Mydriatic (tropicamide and phenylephrine) — 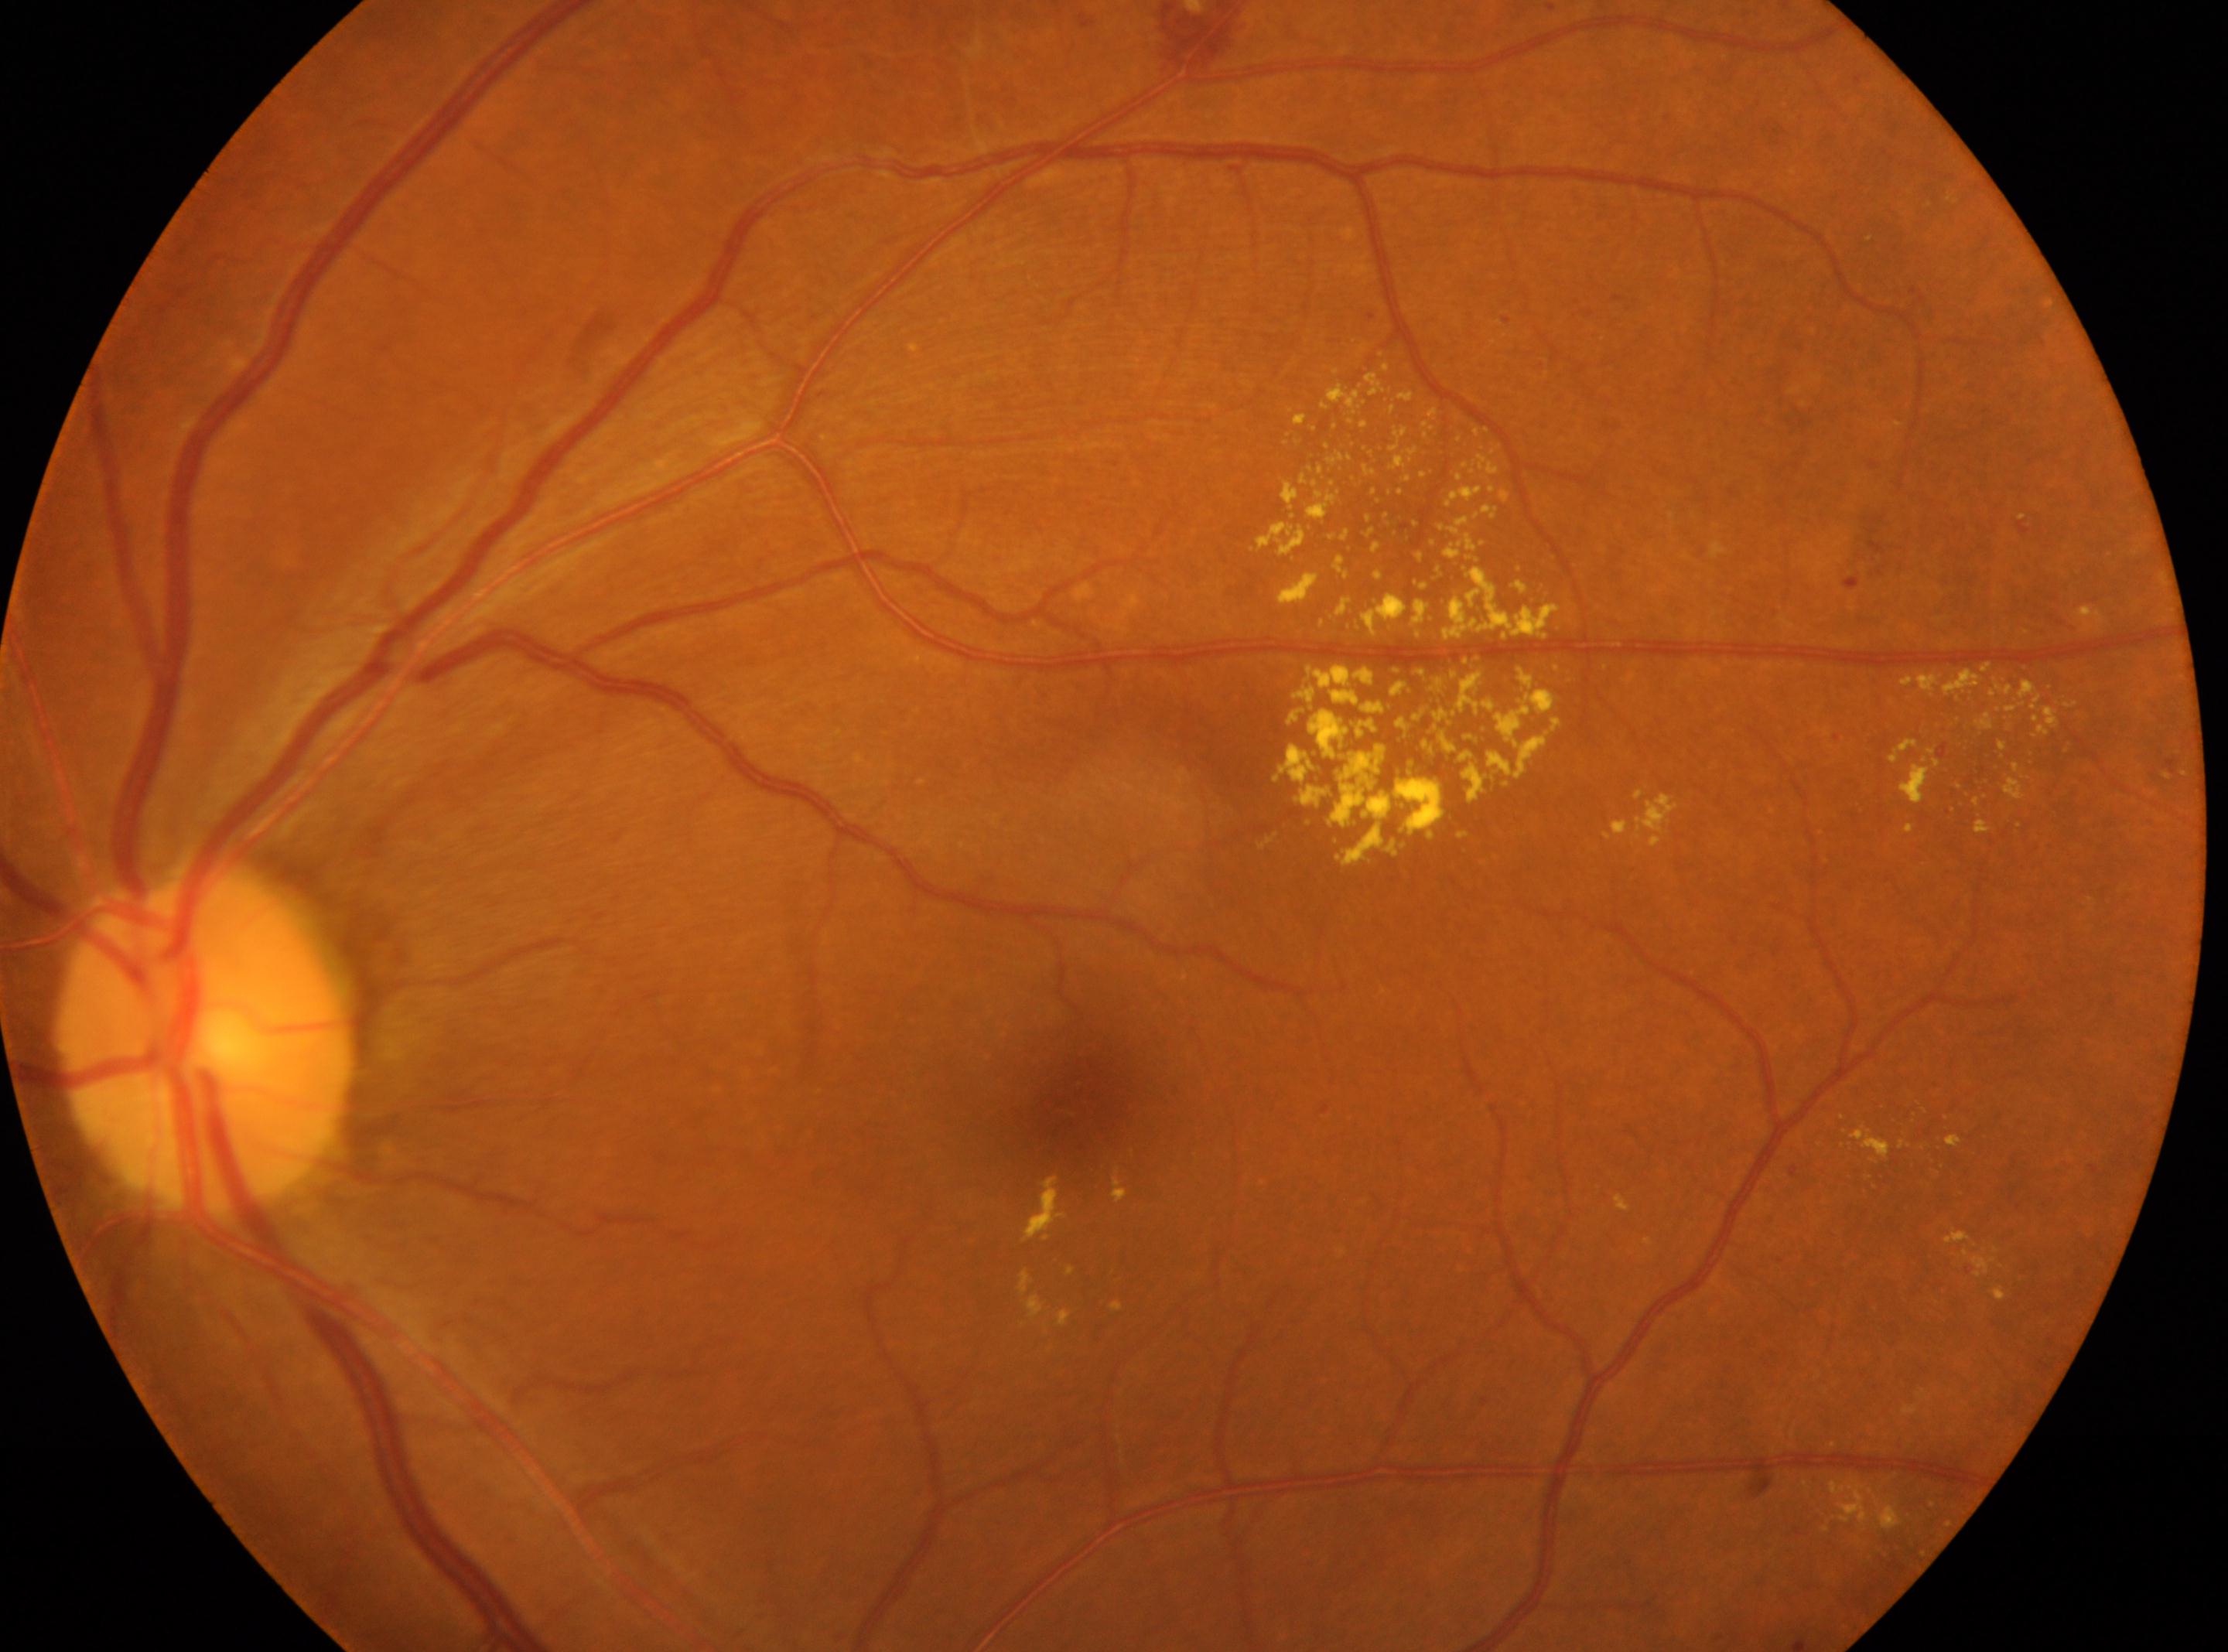

This is the oculus sinister.
Macula center located at (x=1066, y=1108).
DR stage is grade 2 (moderate NPDR) — more than just microaneurysms but less than severe NPDR.
Optic disc: (x=204, y=1041).